Color fundus image — 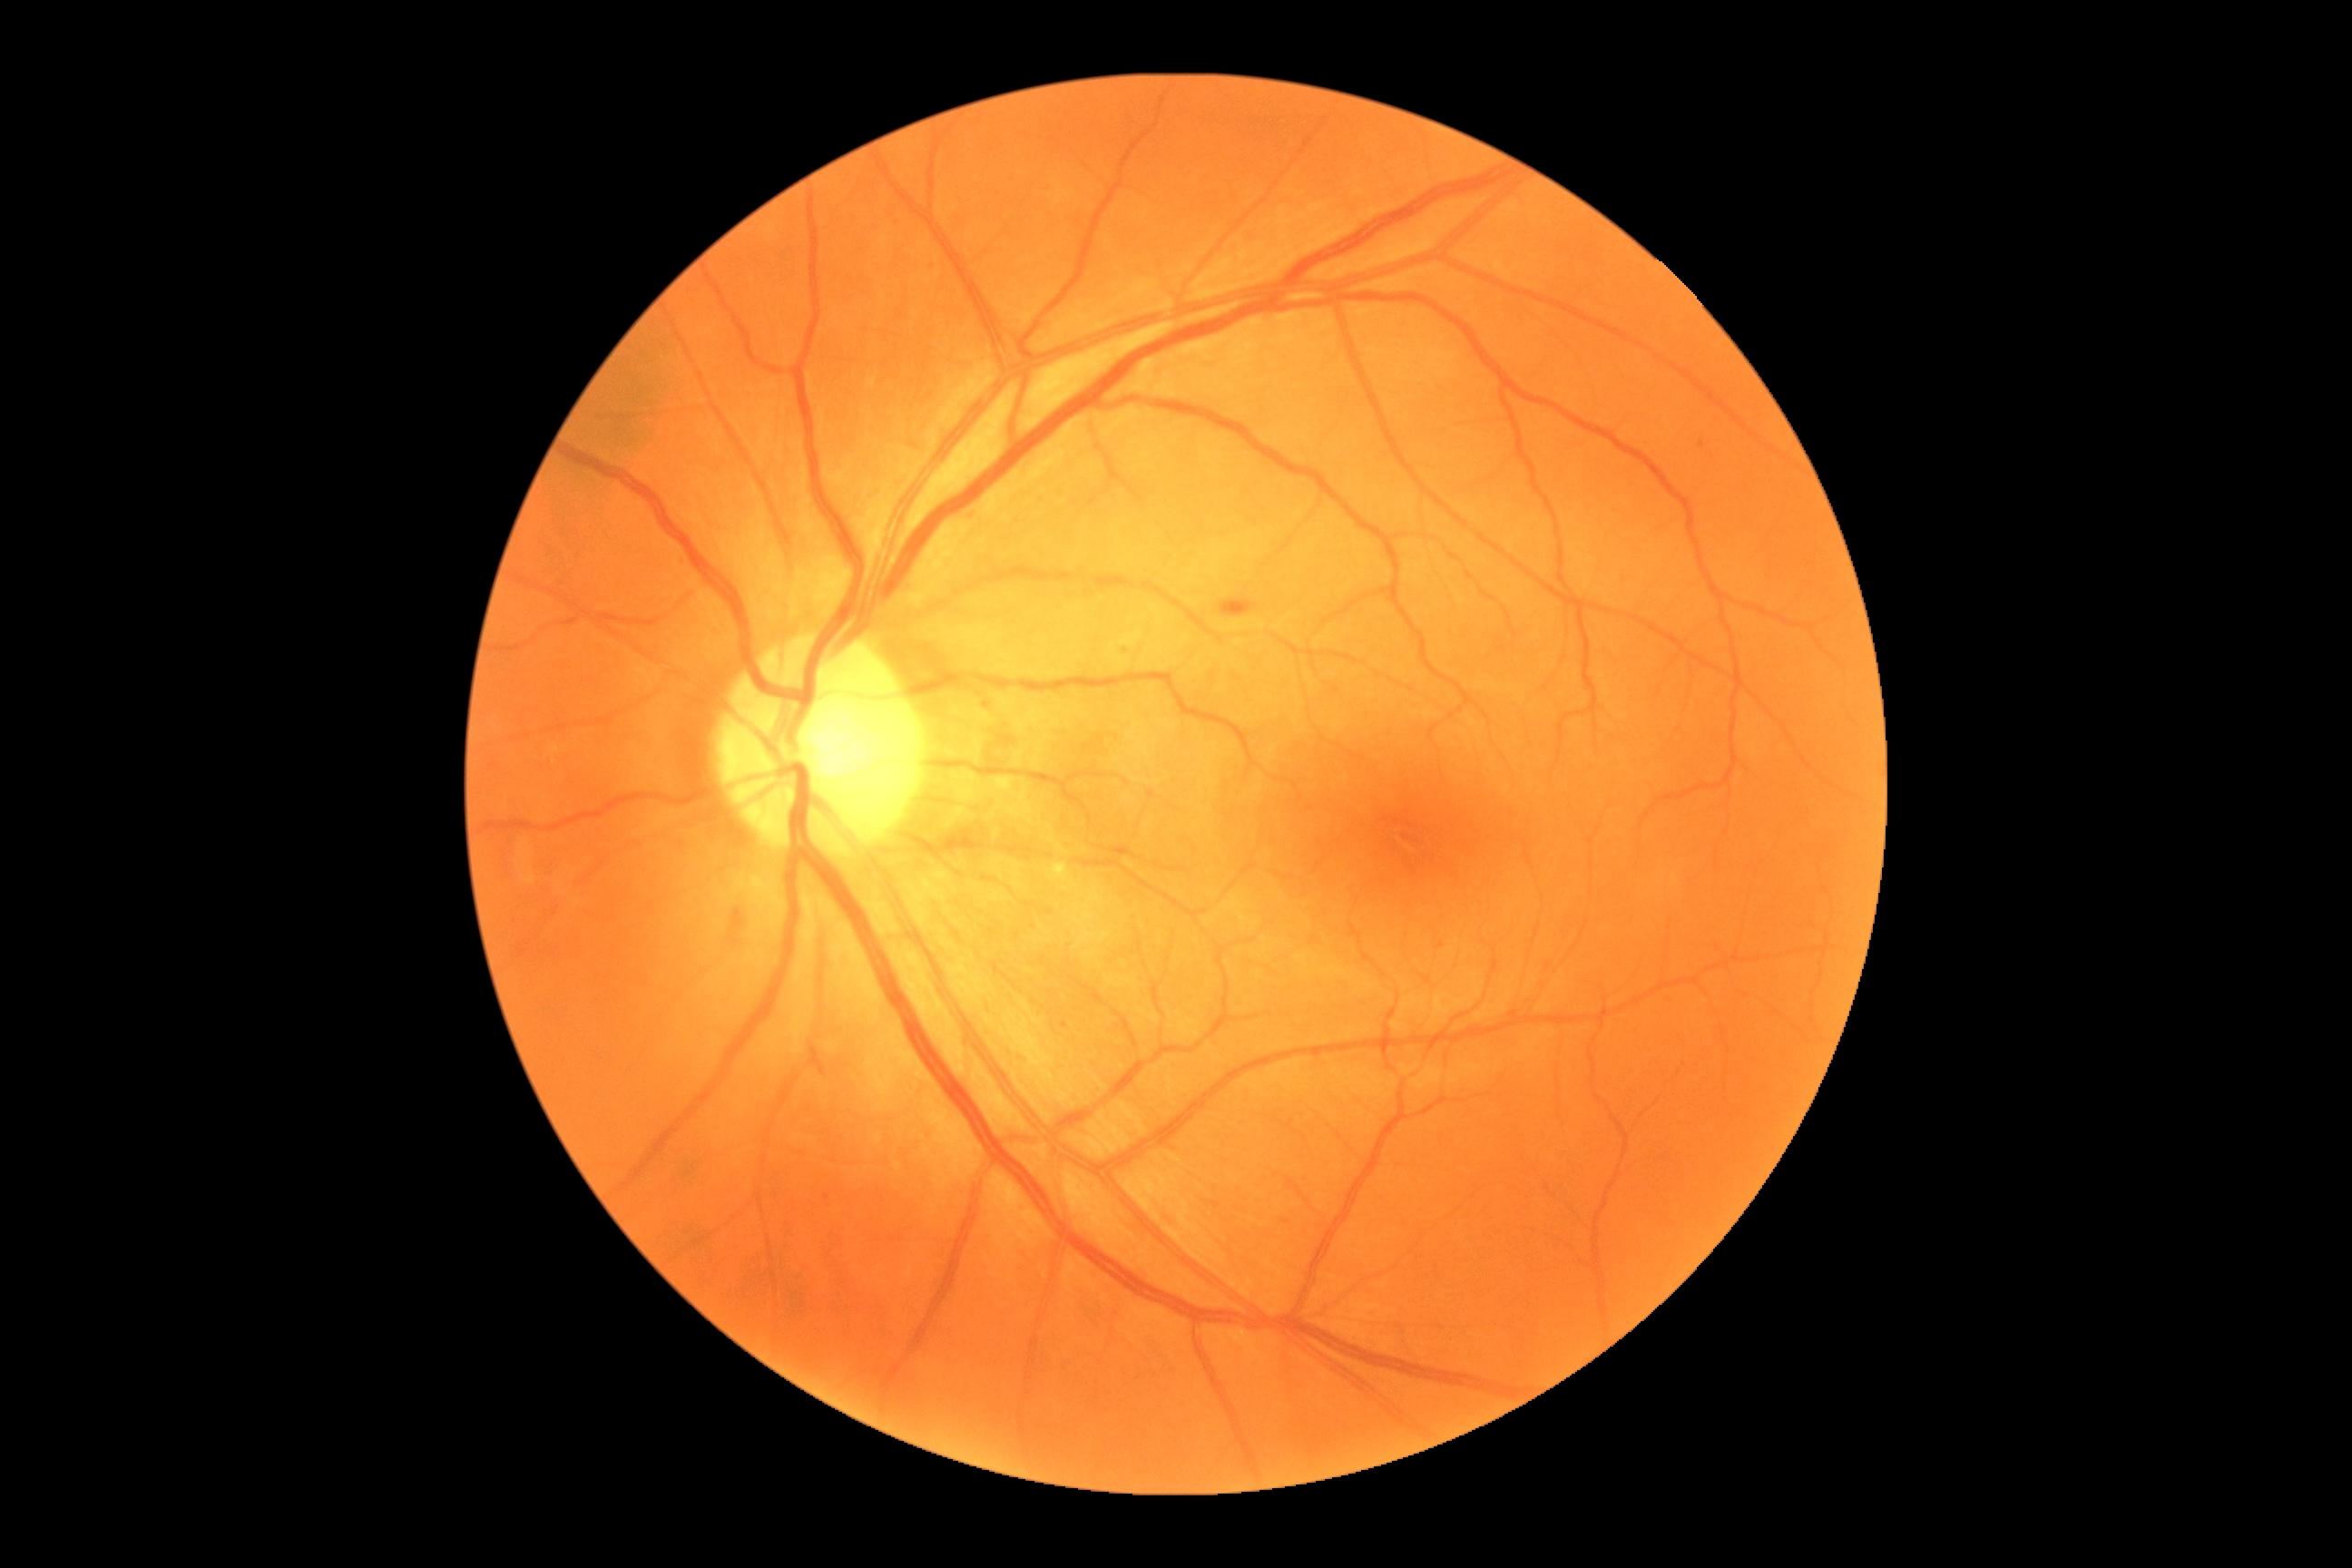   dr_grade: moderate non-proliferative diabetic retinopathy (grade 2)